2212x1659: 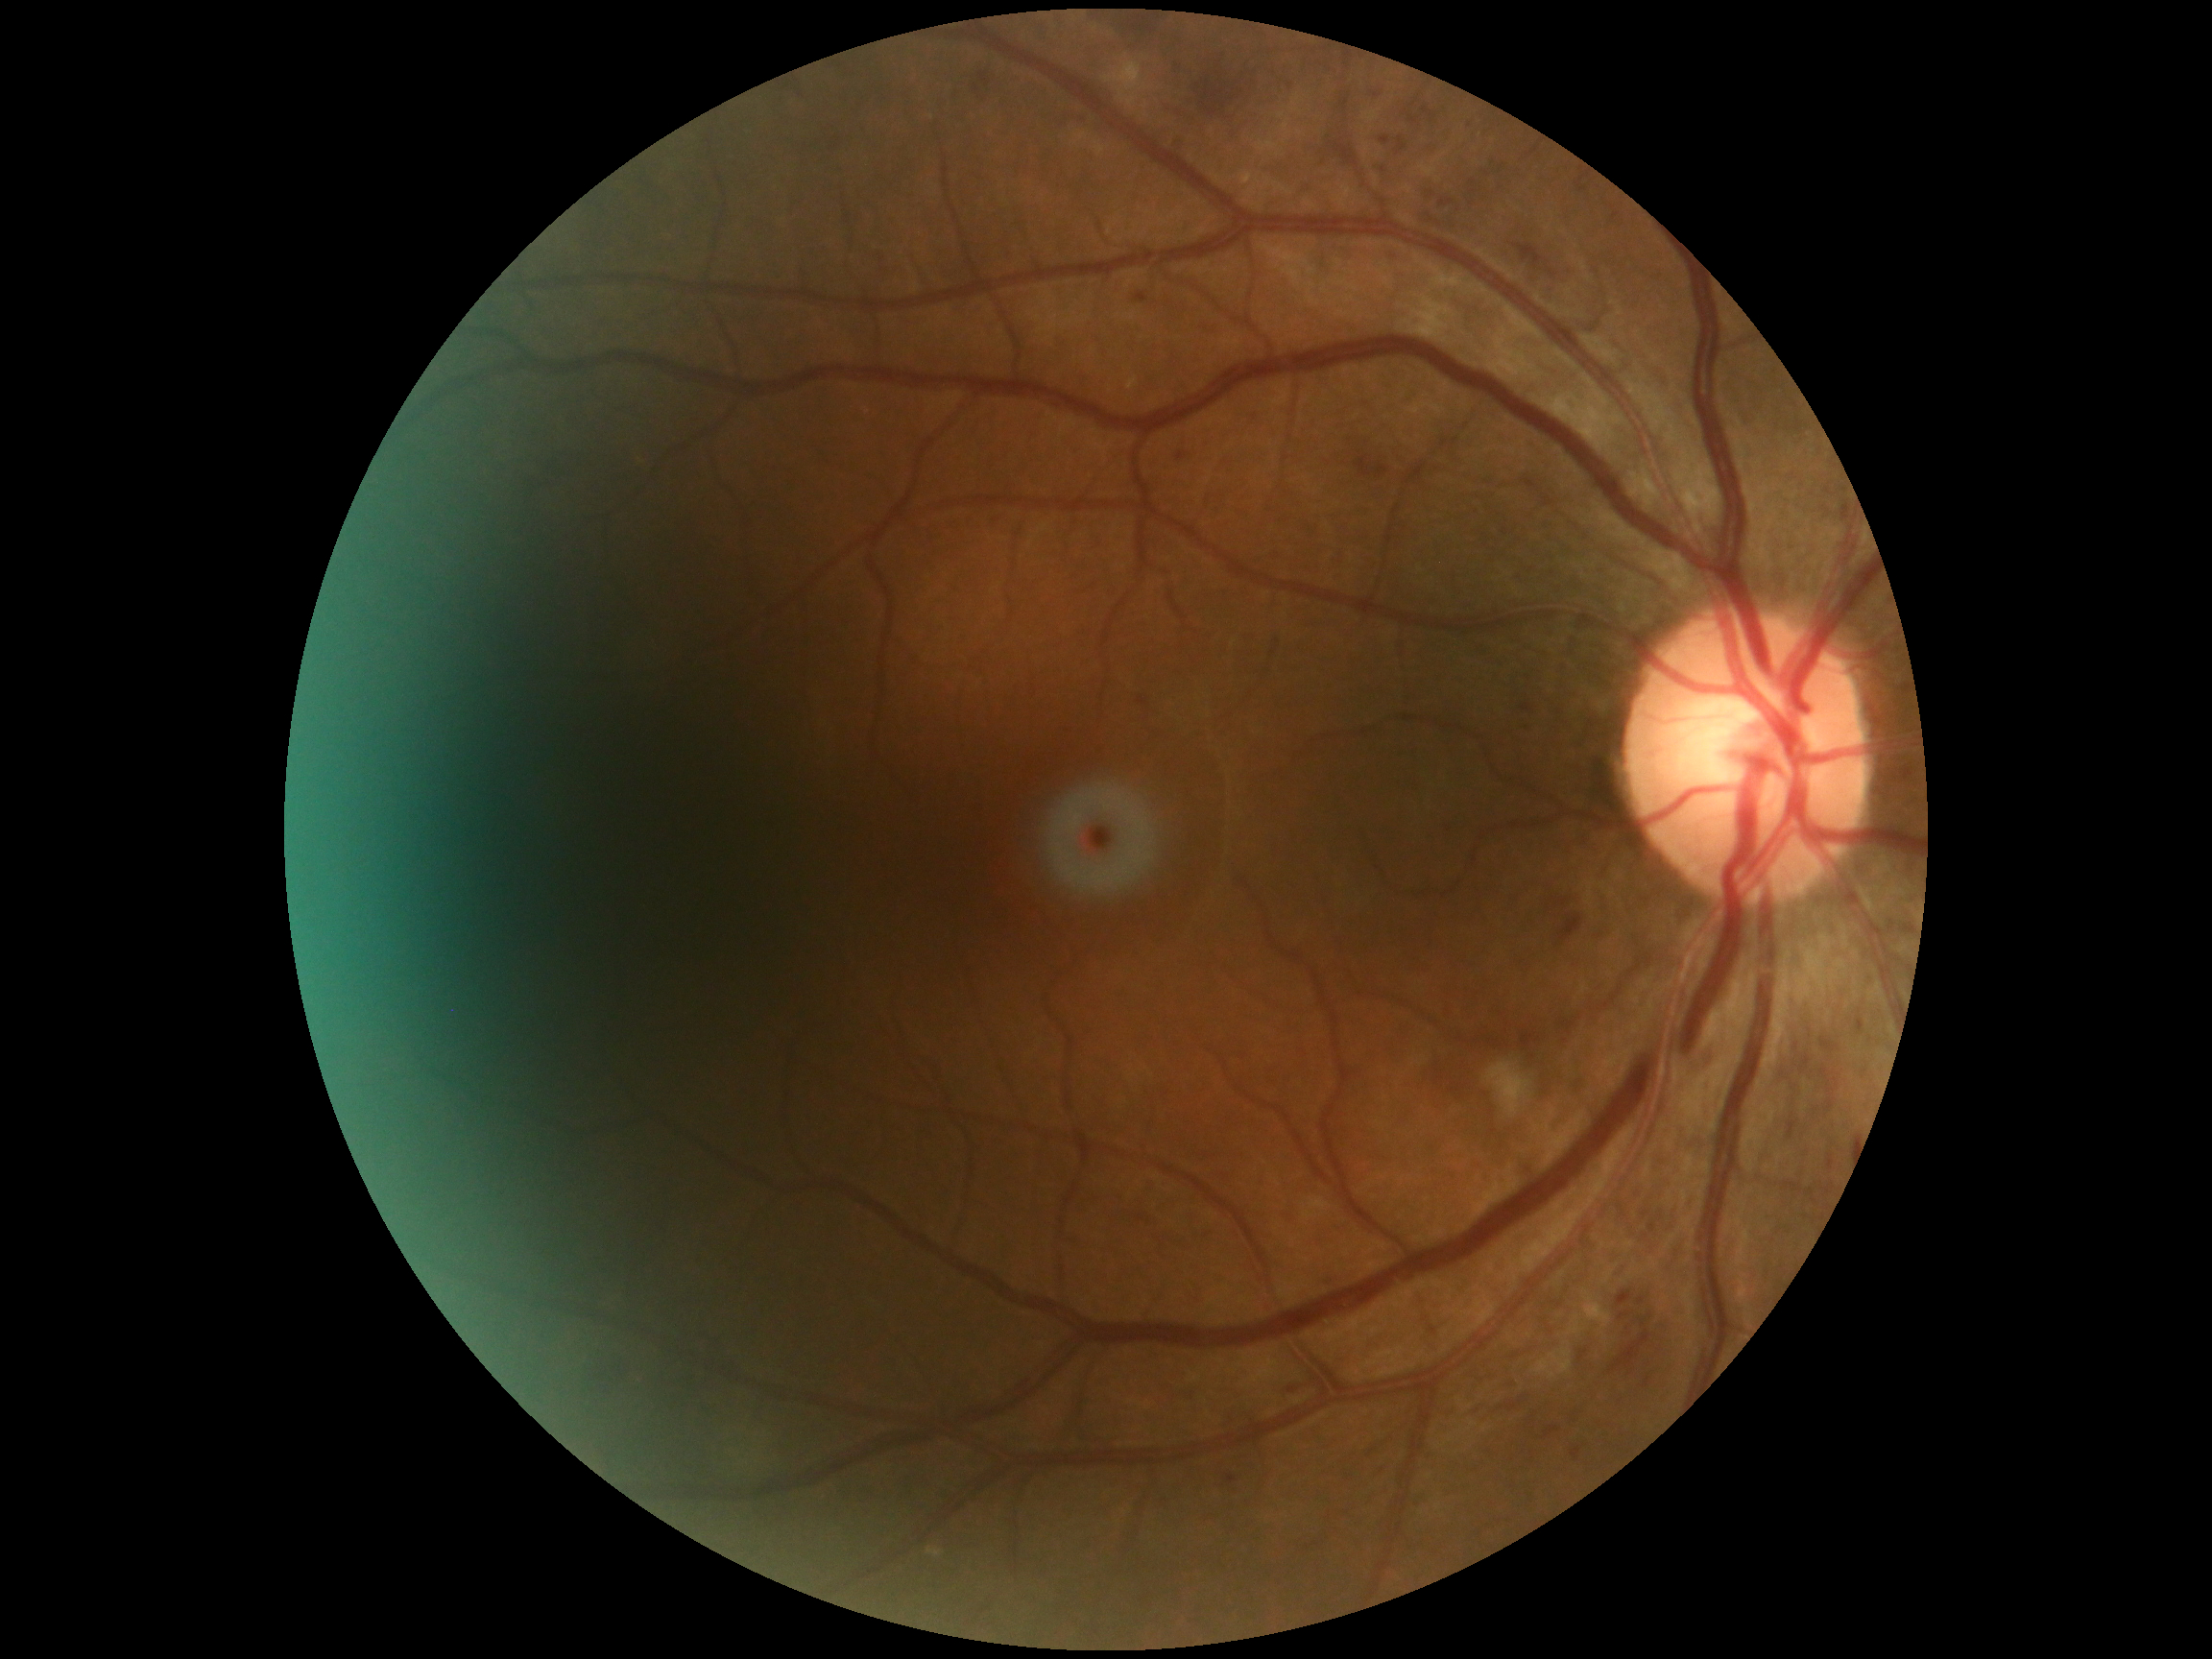
{"dr_category": "non-proliferative diabetic retinopathy", "dr_grade": "2/4"}